Wide-field fundus photograph from neonatal ROP screening. Captured with the Phoenix ICON (100° field of view): 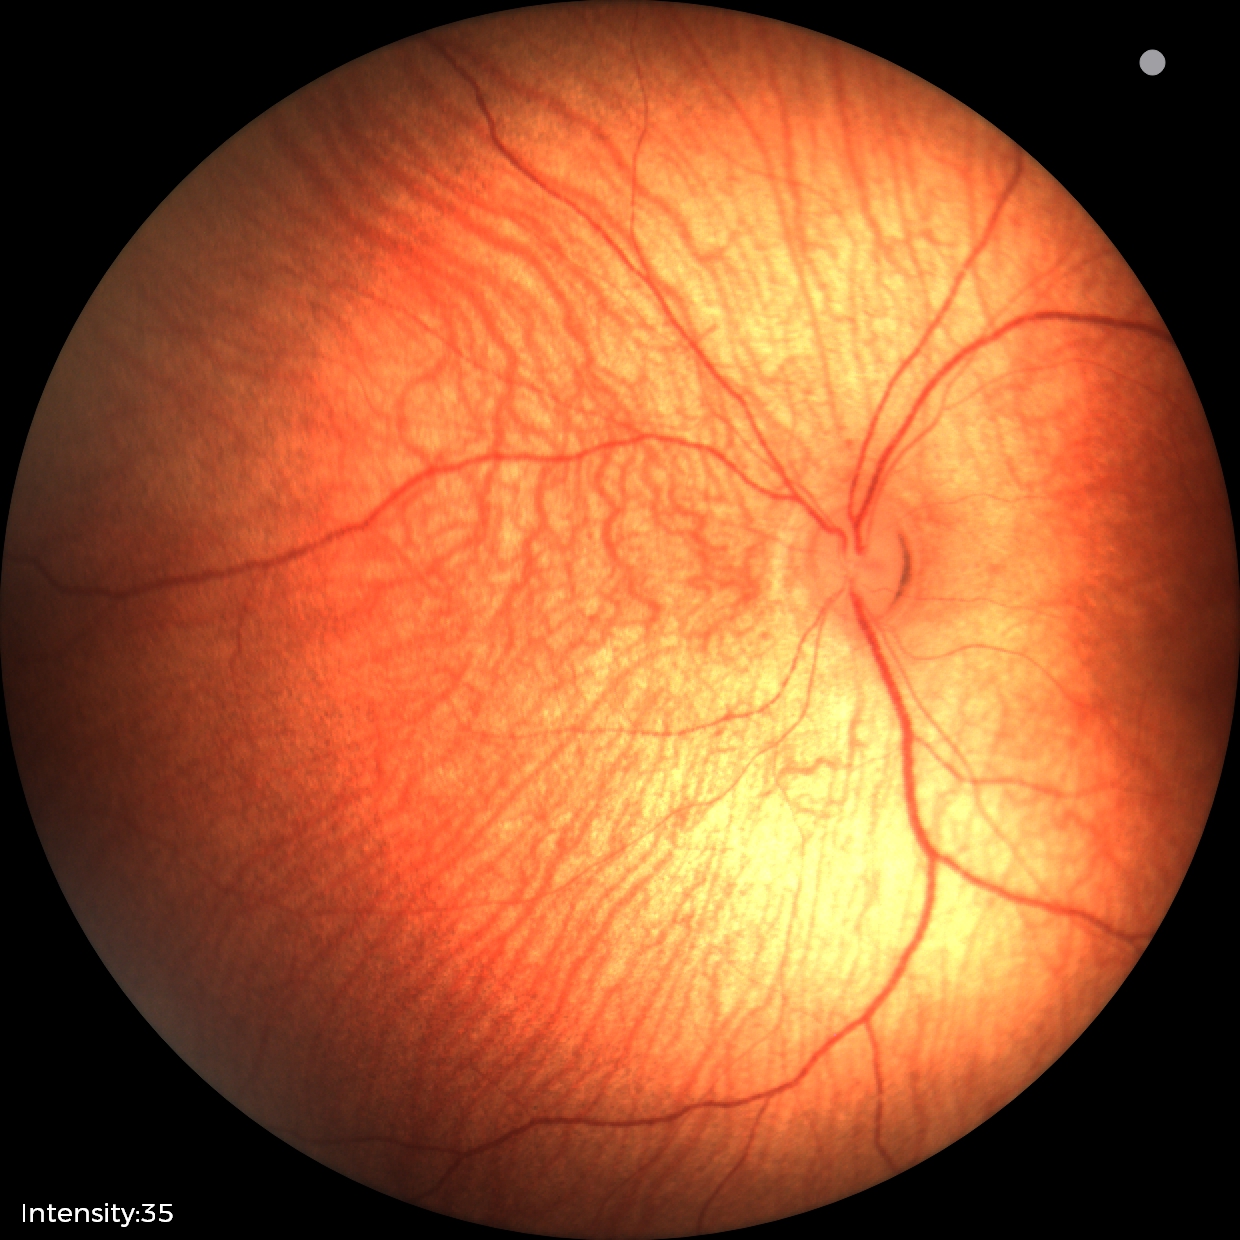 Q: What is the diagnosis from this examination?
A: normal fundus examination